Wide-field fundus photograph of an infant · 640x480 · 130° field of view (Clarity RetCam 3).
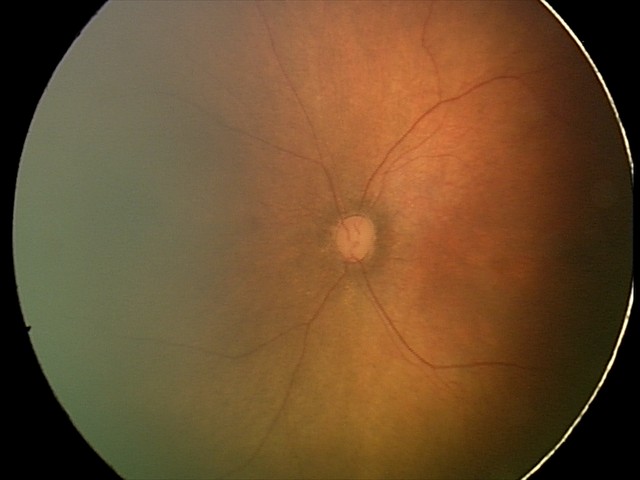

No retinal pathology identified on screening.